45° field of view.
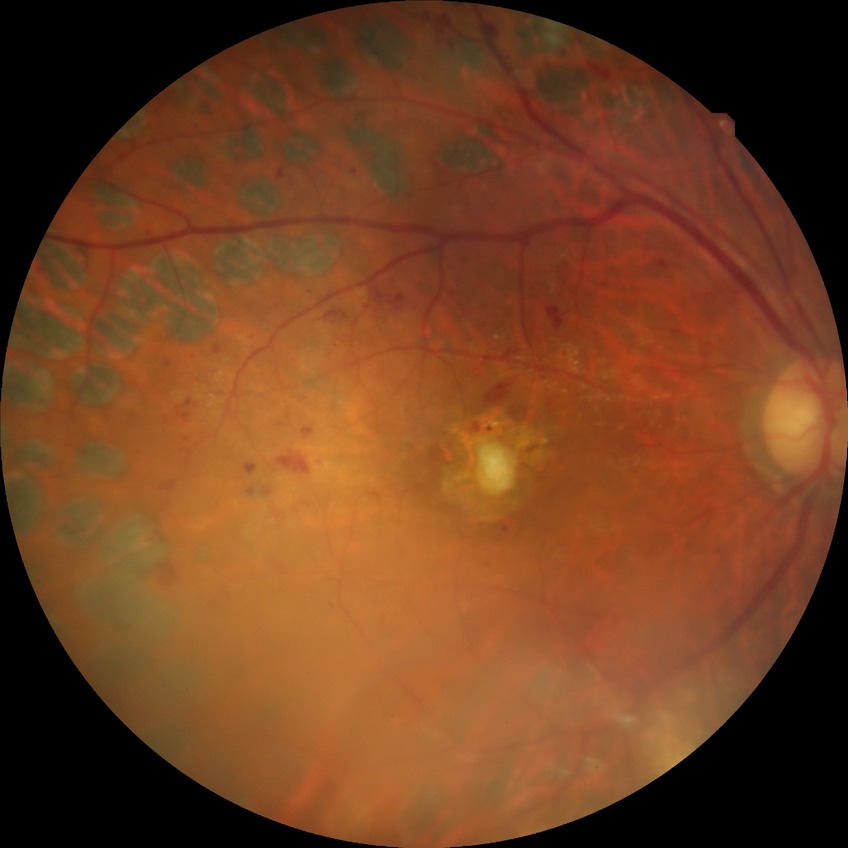 Diabetic retinopathy (DR) is PDR (proliferative diabetic retinopathy).